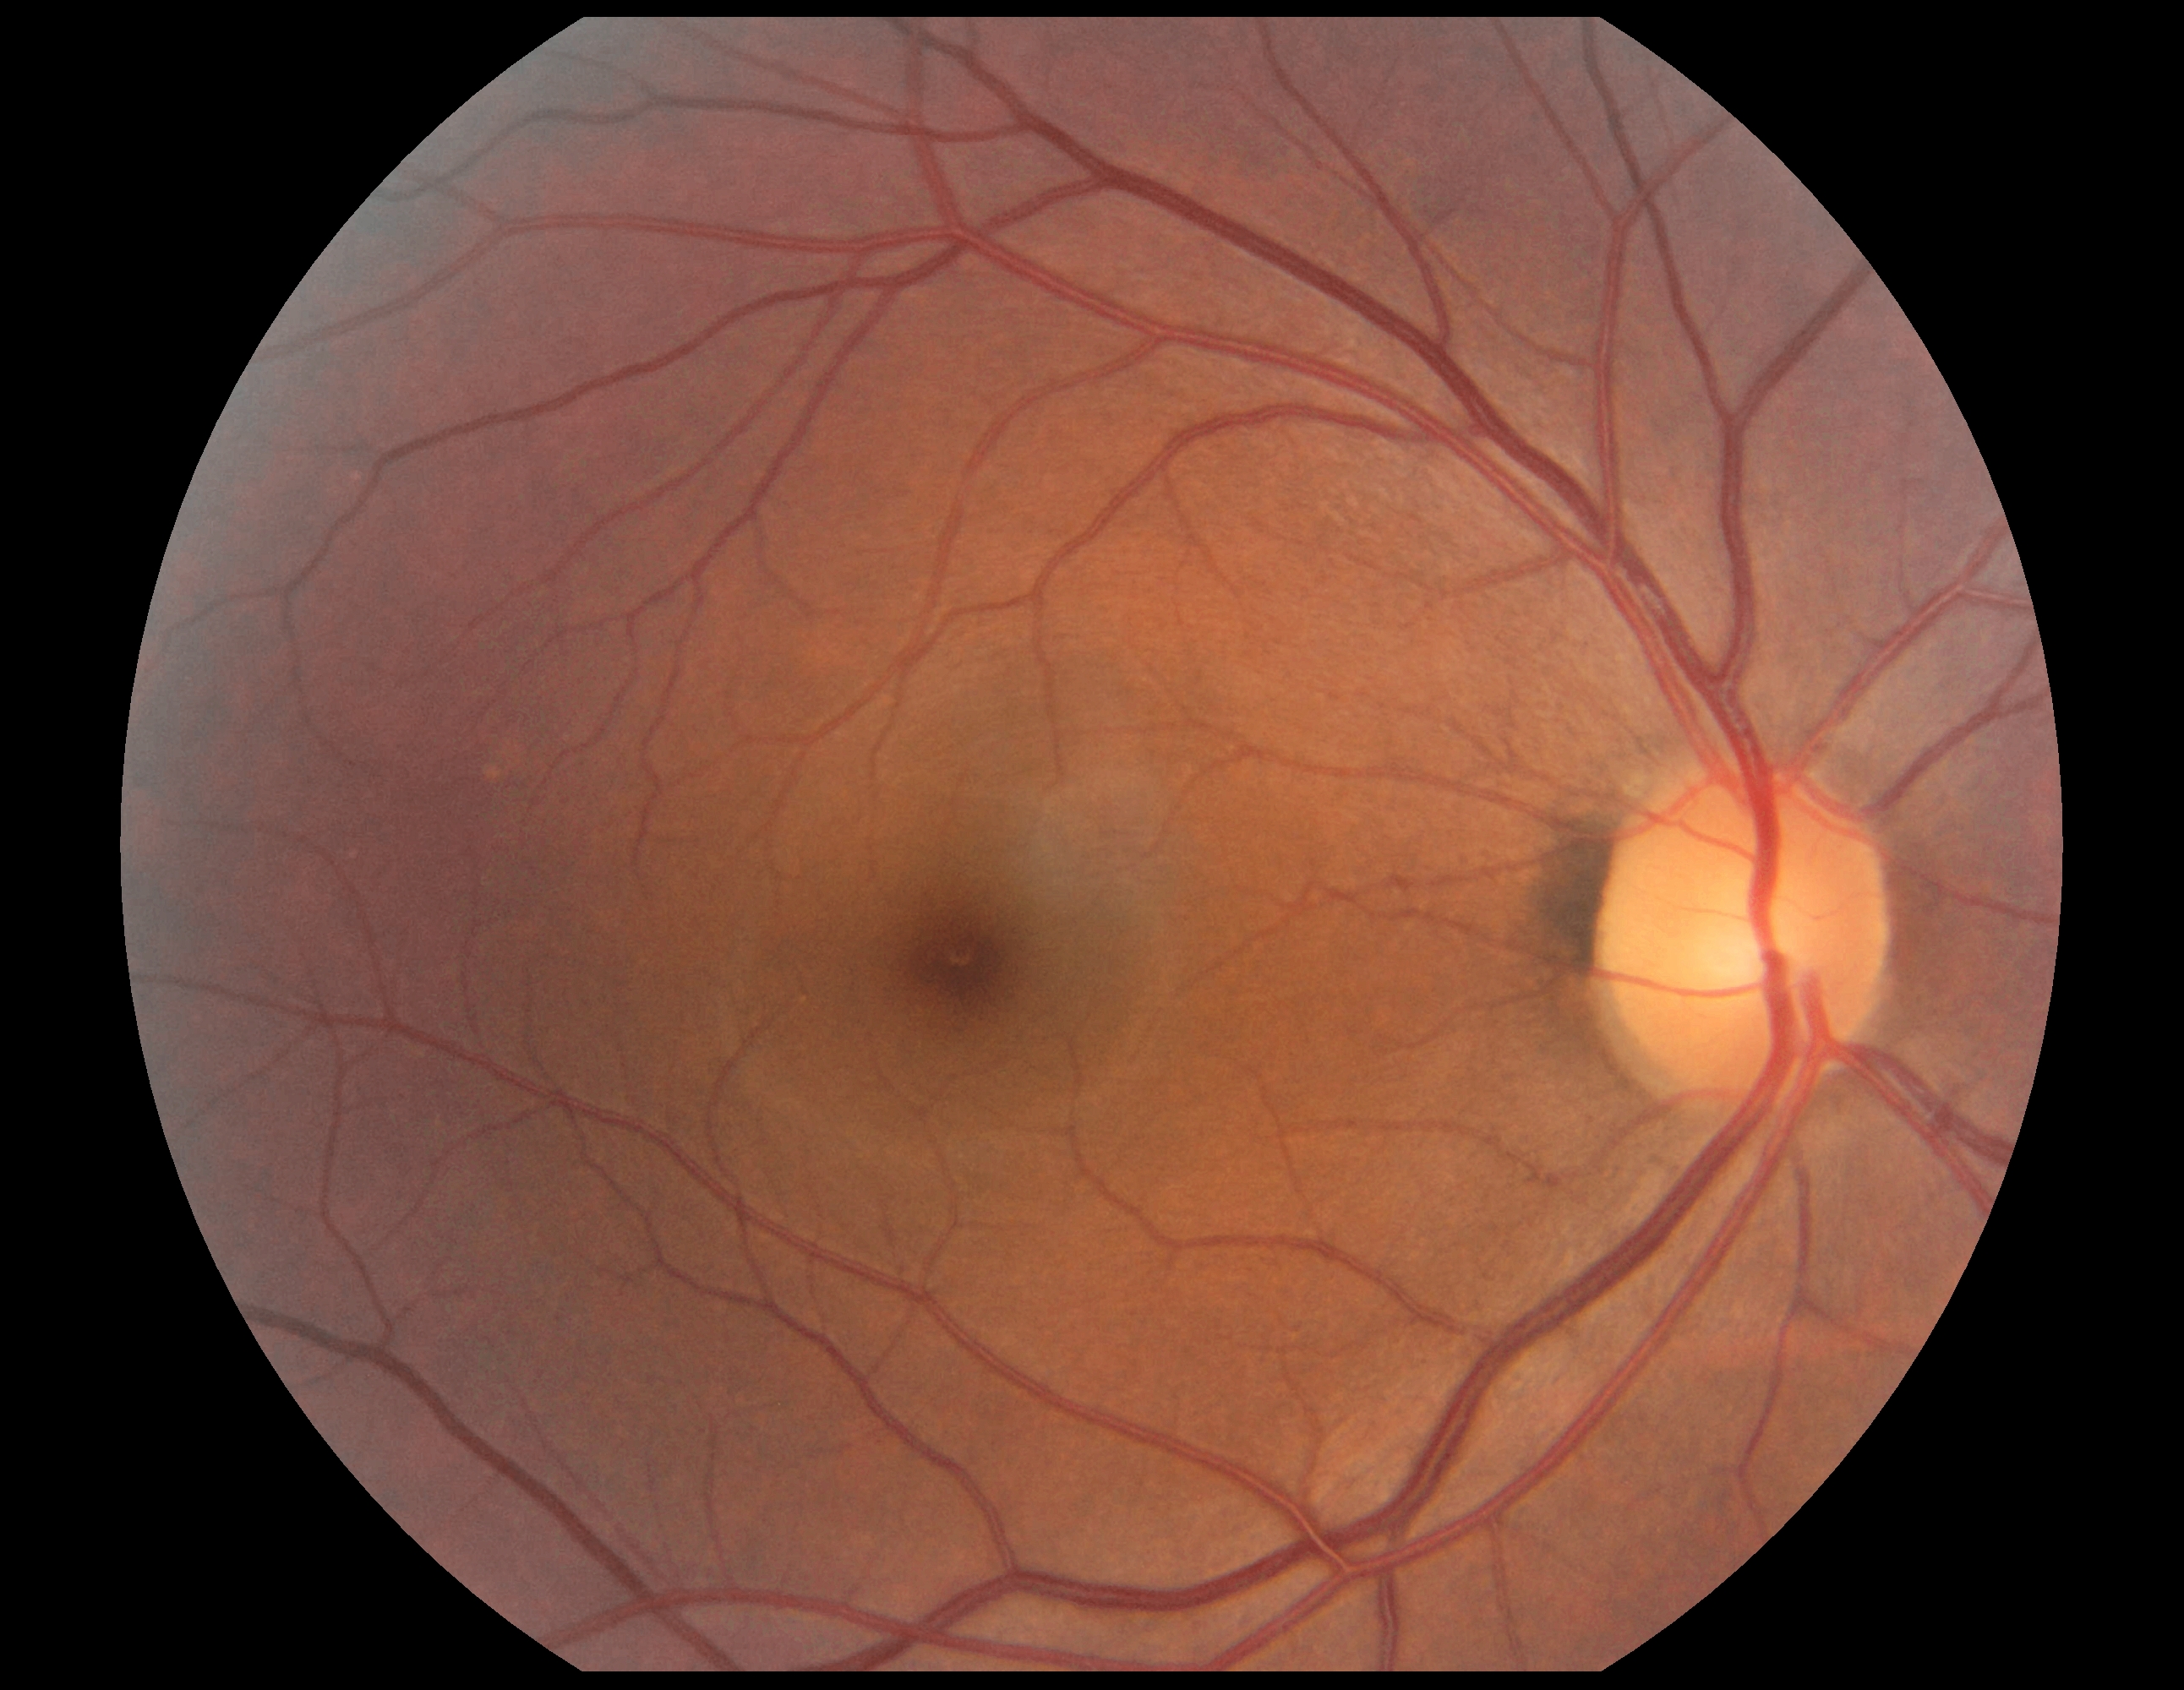

DR grade: 0 (no apparent retinopathy).